1536 by 1152 pixels, color fundus image:
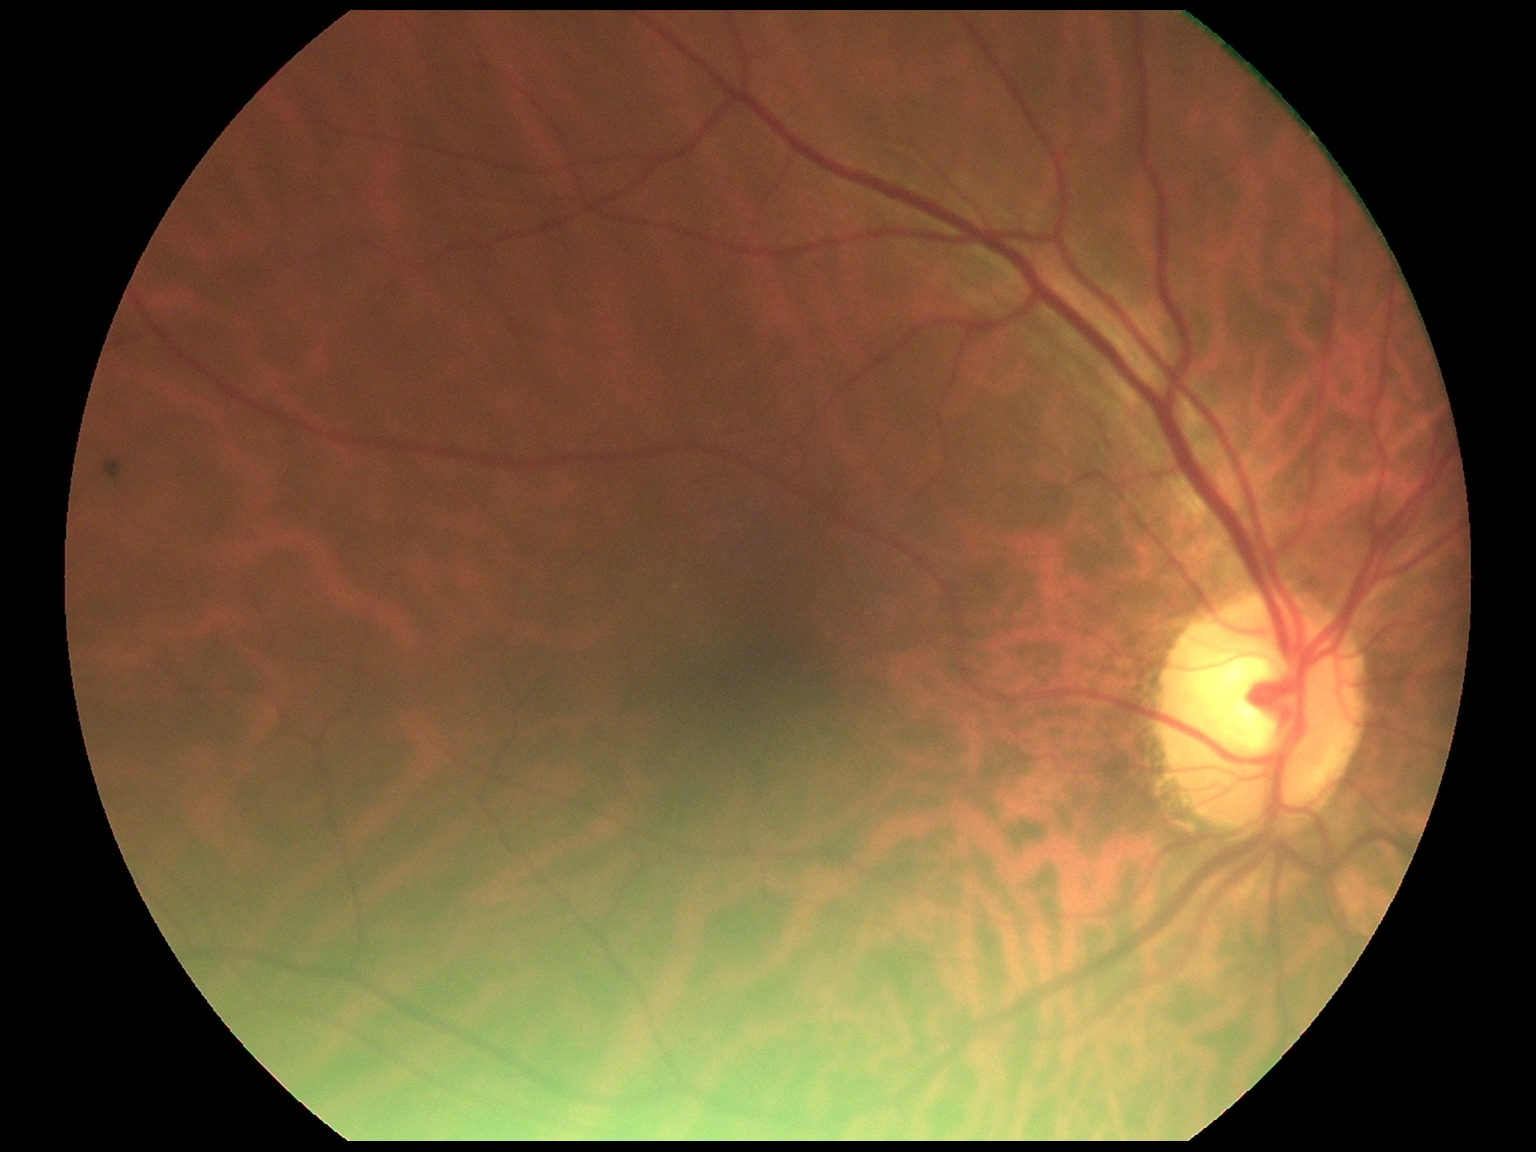

Findings:
– diabetic retinopathy grade — 0 (no apparent retinopathy)
– DR impression — no signs of DR